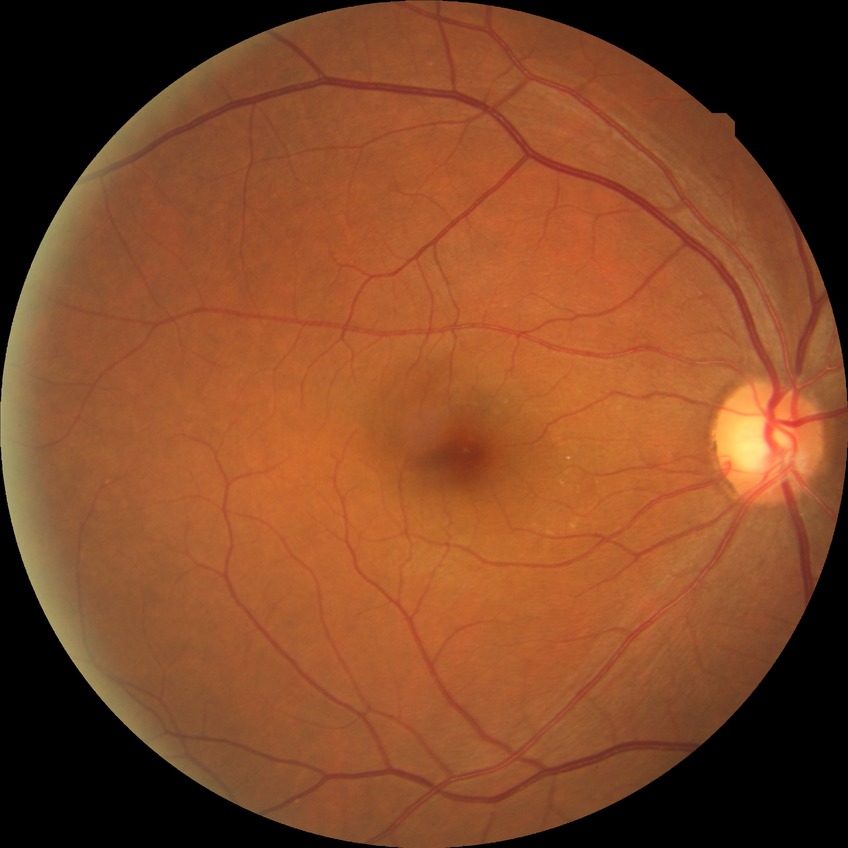
{
  "davis_grade": "NDR"
}